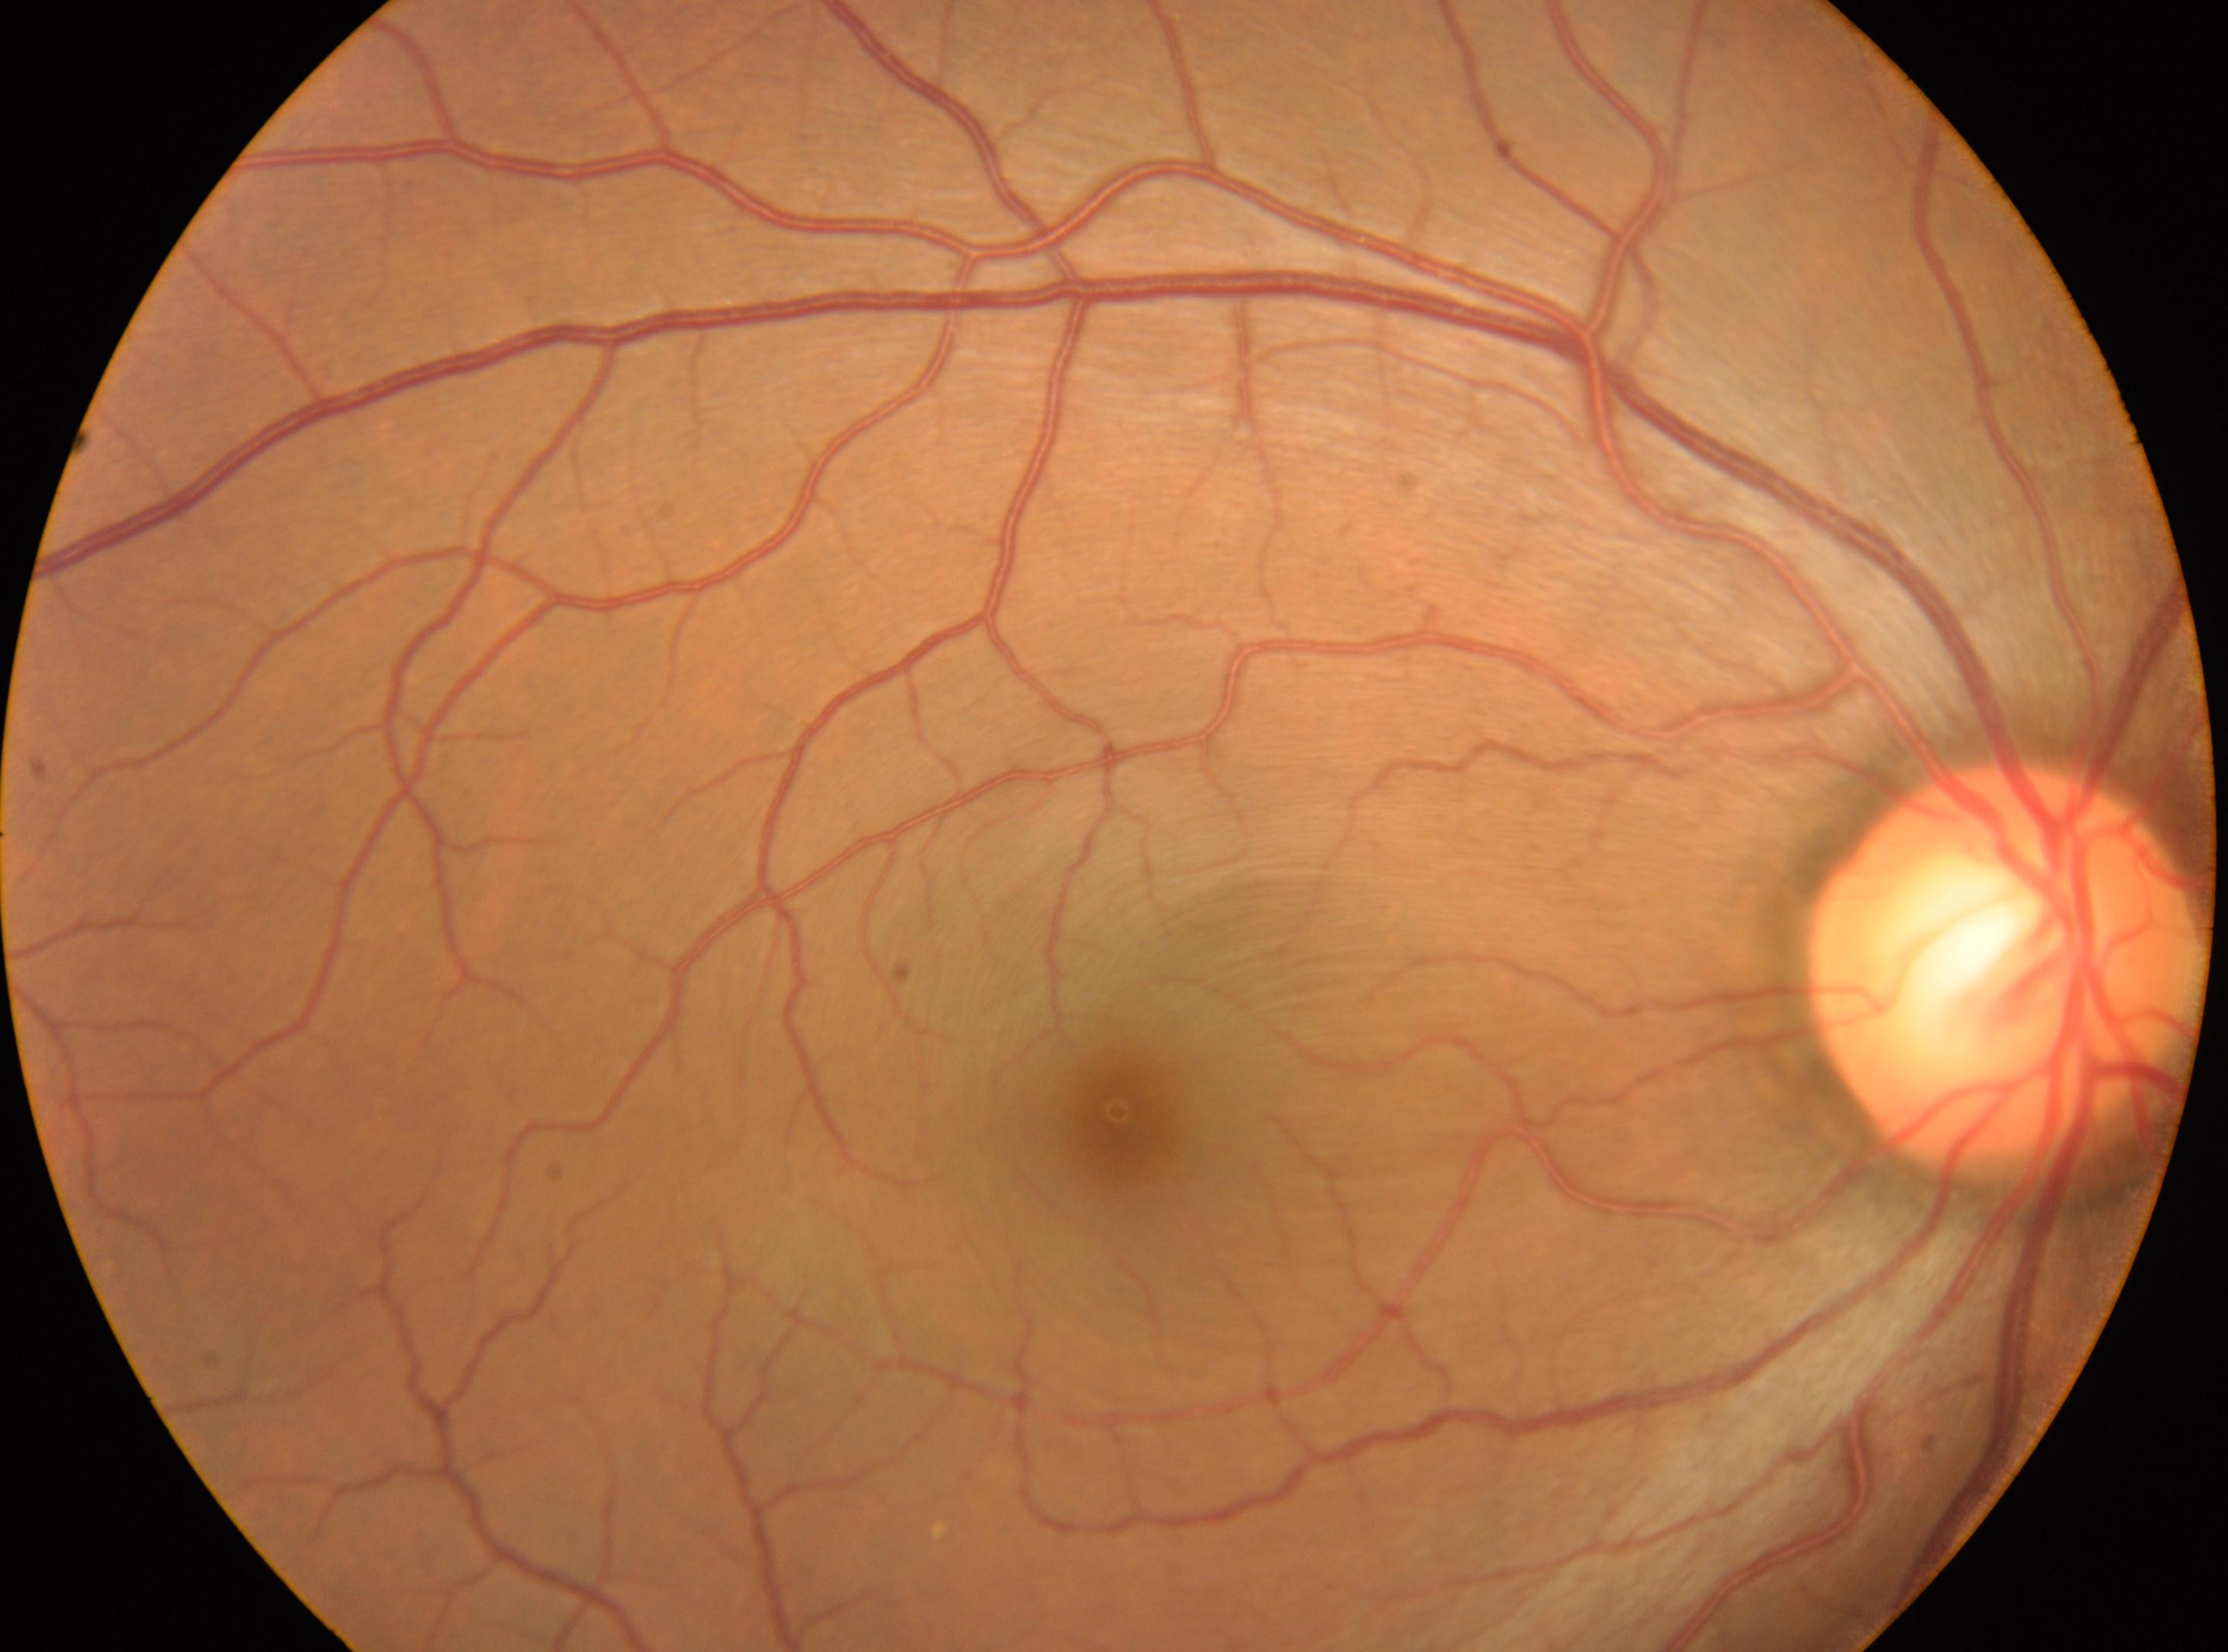
Diabetic retinopathy (DR) is no apparent retinopathy (grade 0) — no visible signs of diabetic retinopathy.
The disc center is at (x=2004, y=964).
Imaged eye: right.
Macula center: (x=1122, y=1120).